Fundus photo — 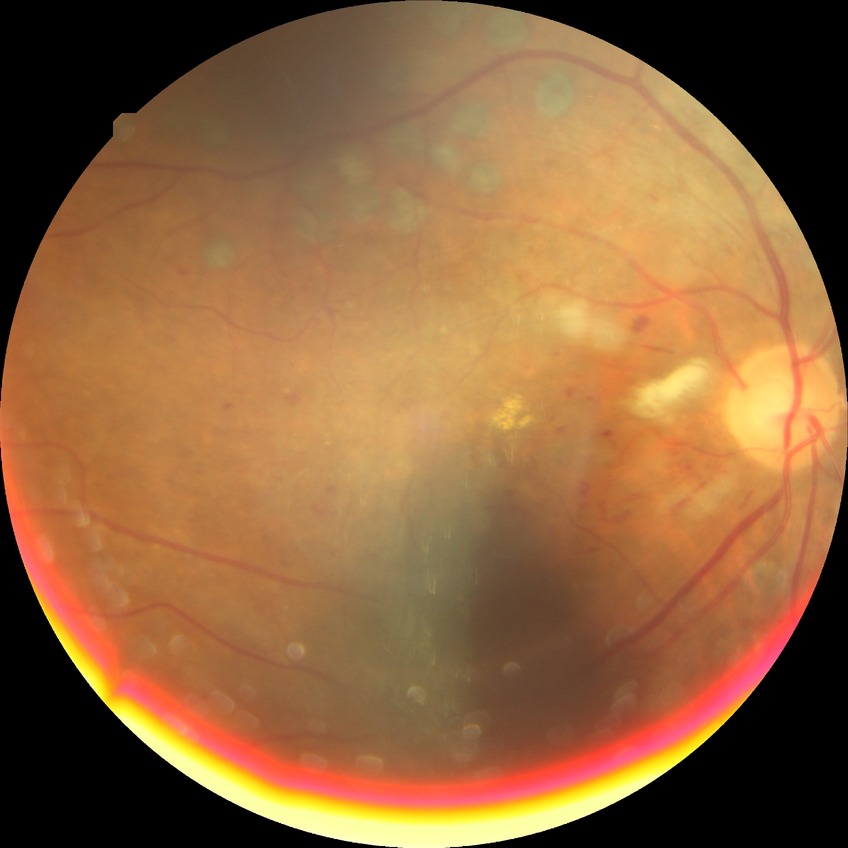 DR class: non-proliferative diabetic retinopathy; Davis stage: PPDR.